Camera: NIDEK AFC-230: 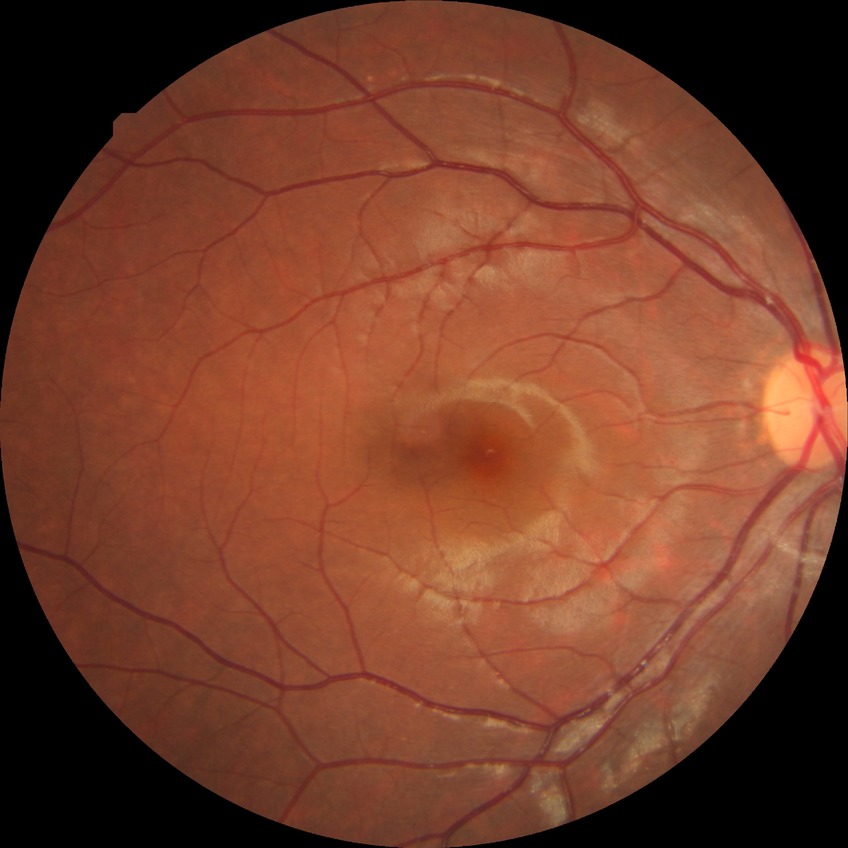

* retinopathy grade — no diabetic retinopathy